Image size 1932x1916 · 45° field of view · retinal fundus photograph — 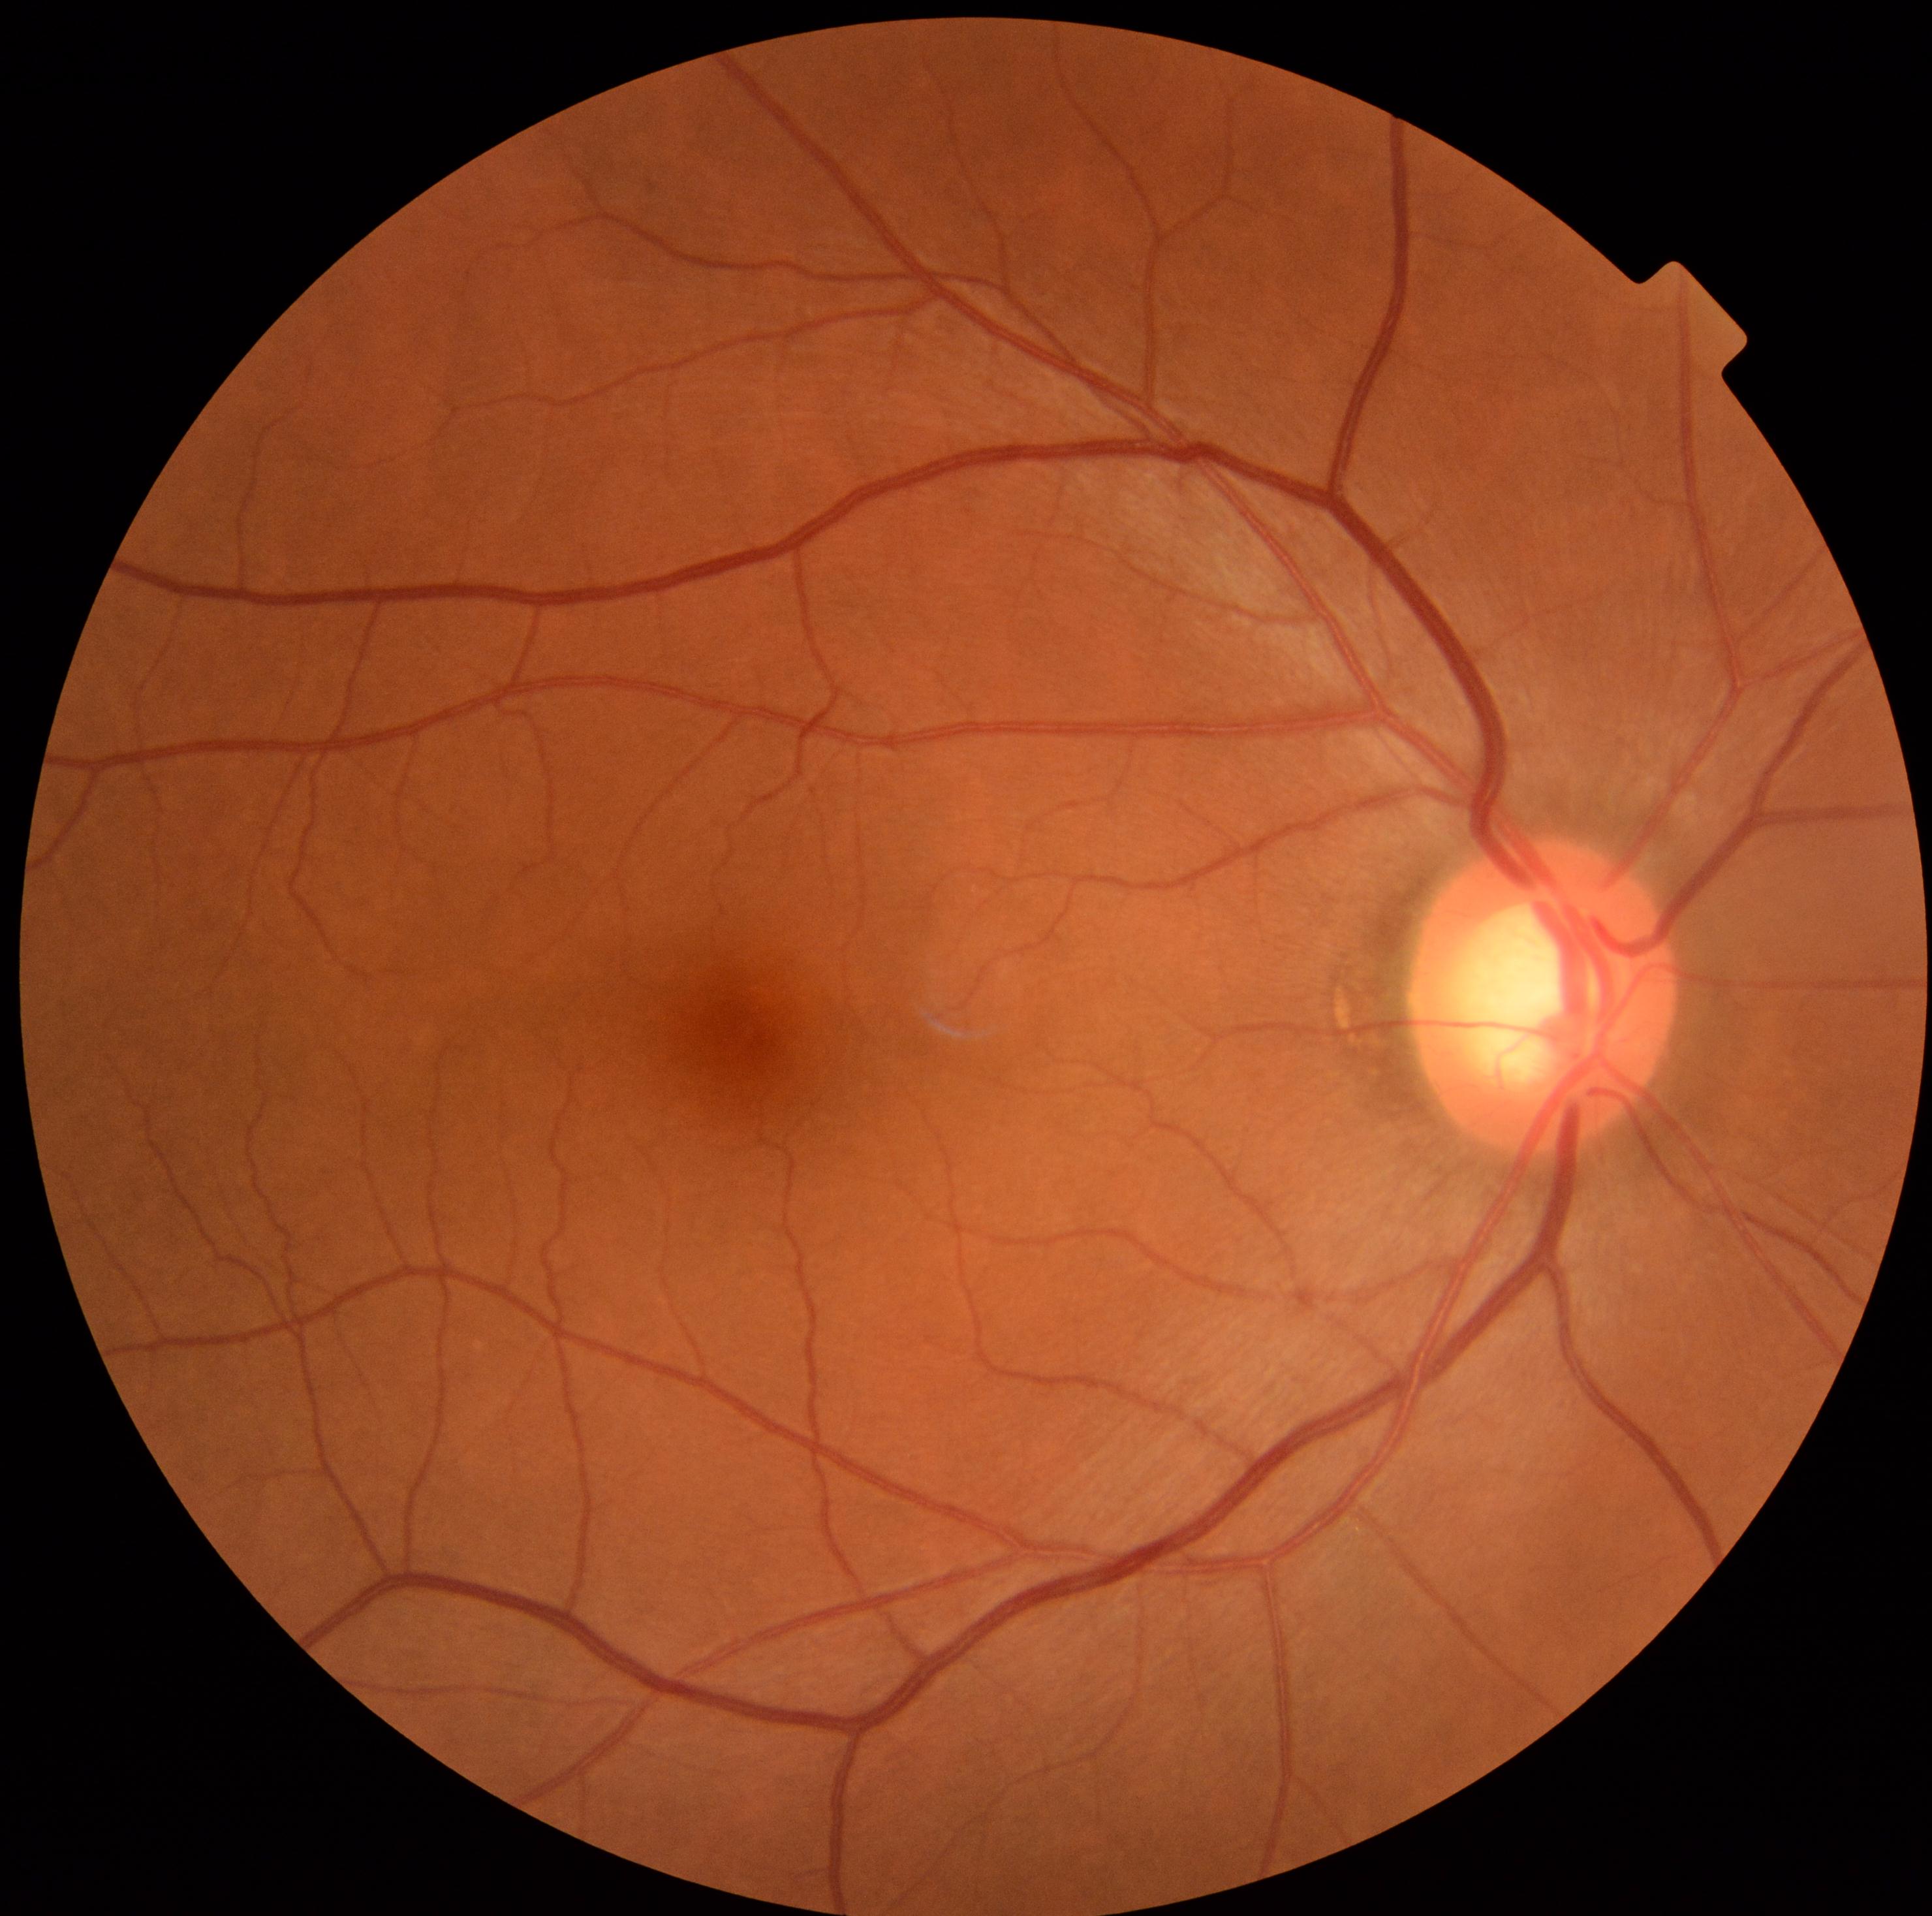

Diabetic retinopathy: grade 0 (no apparent retinopathy).